Pediatric wide-field fundus photograph; 130° field of view (Clarity RetCam 3); 640x480: 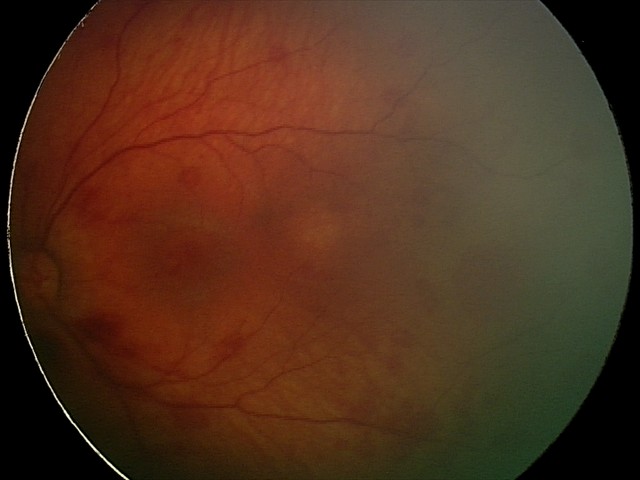

Series diagnosed as retinal hemorrhages.